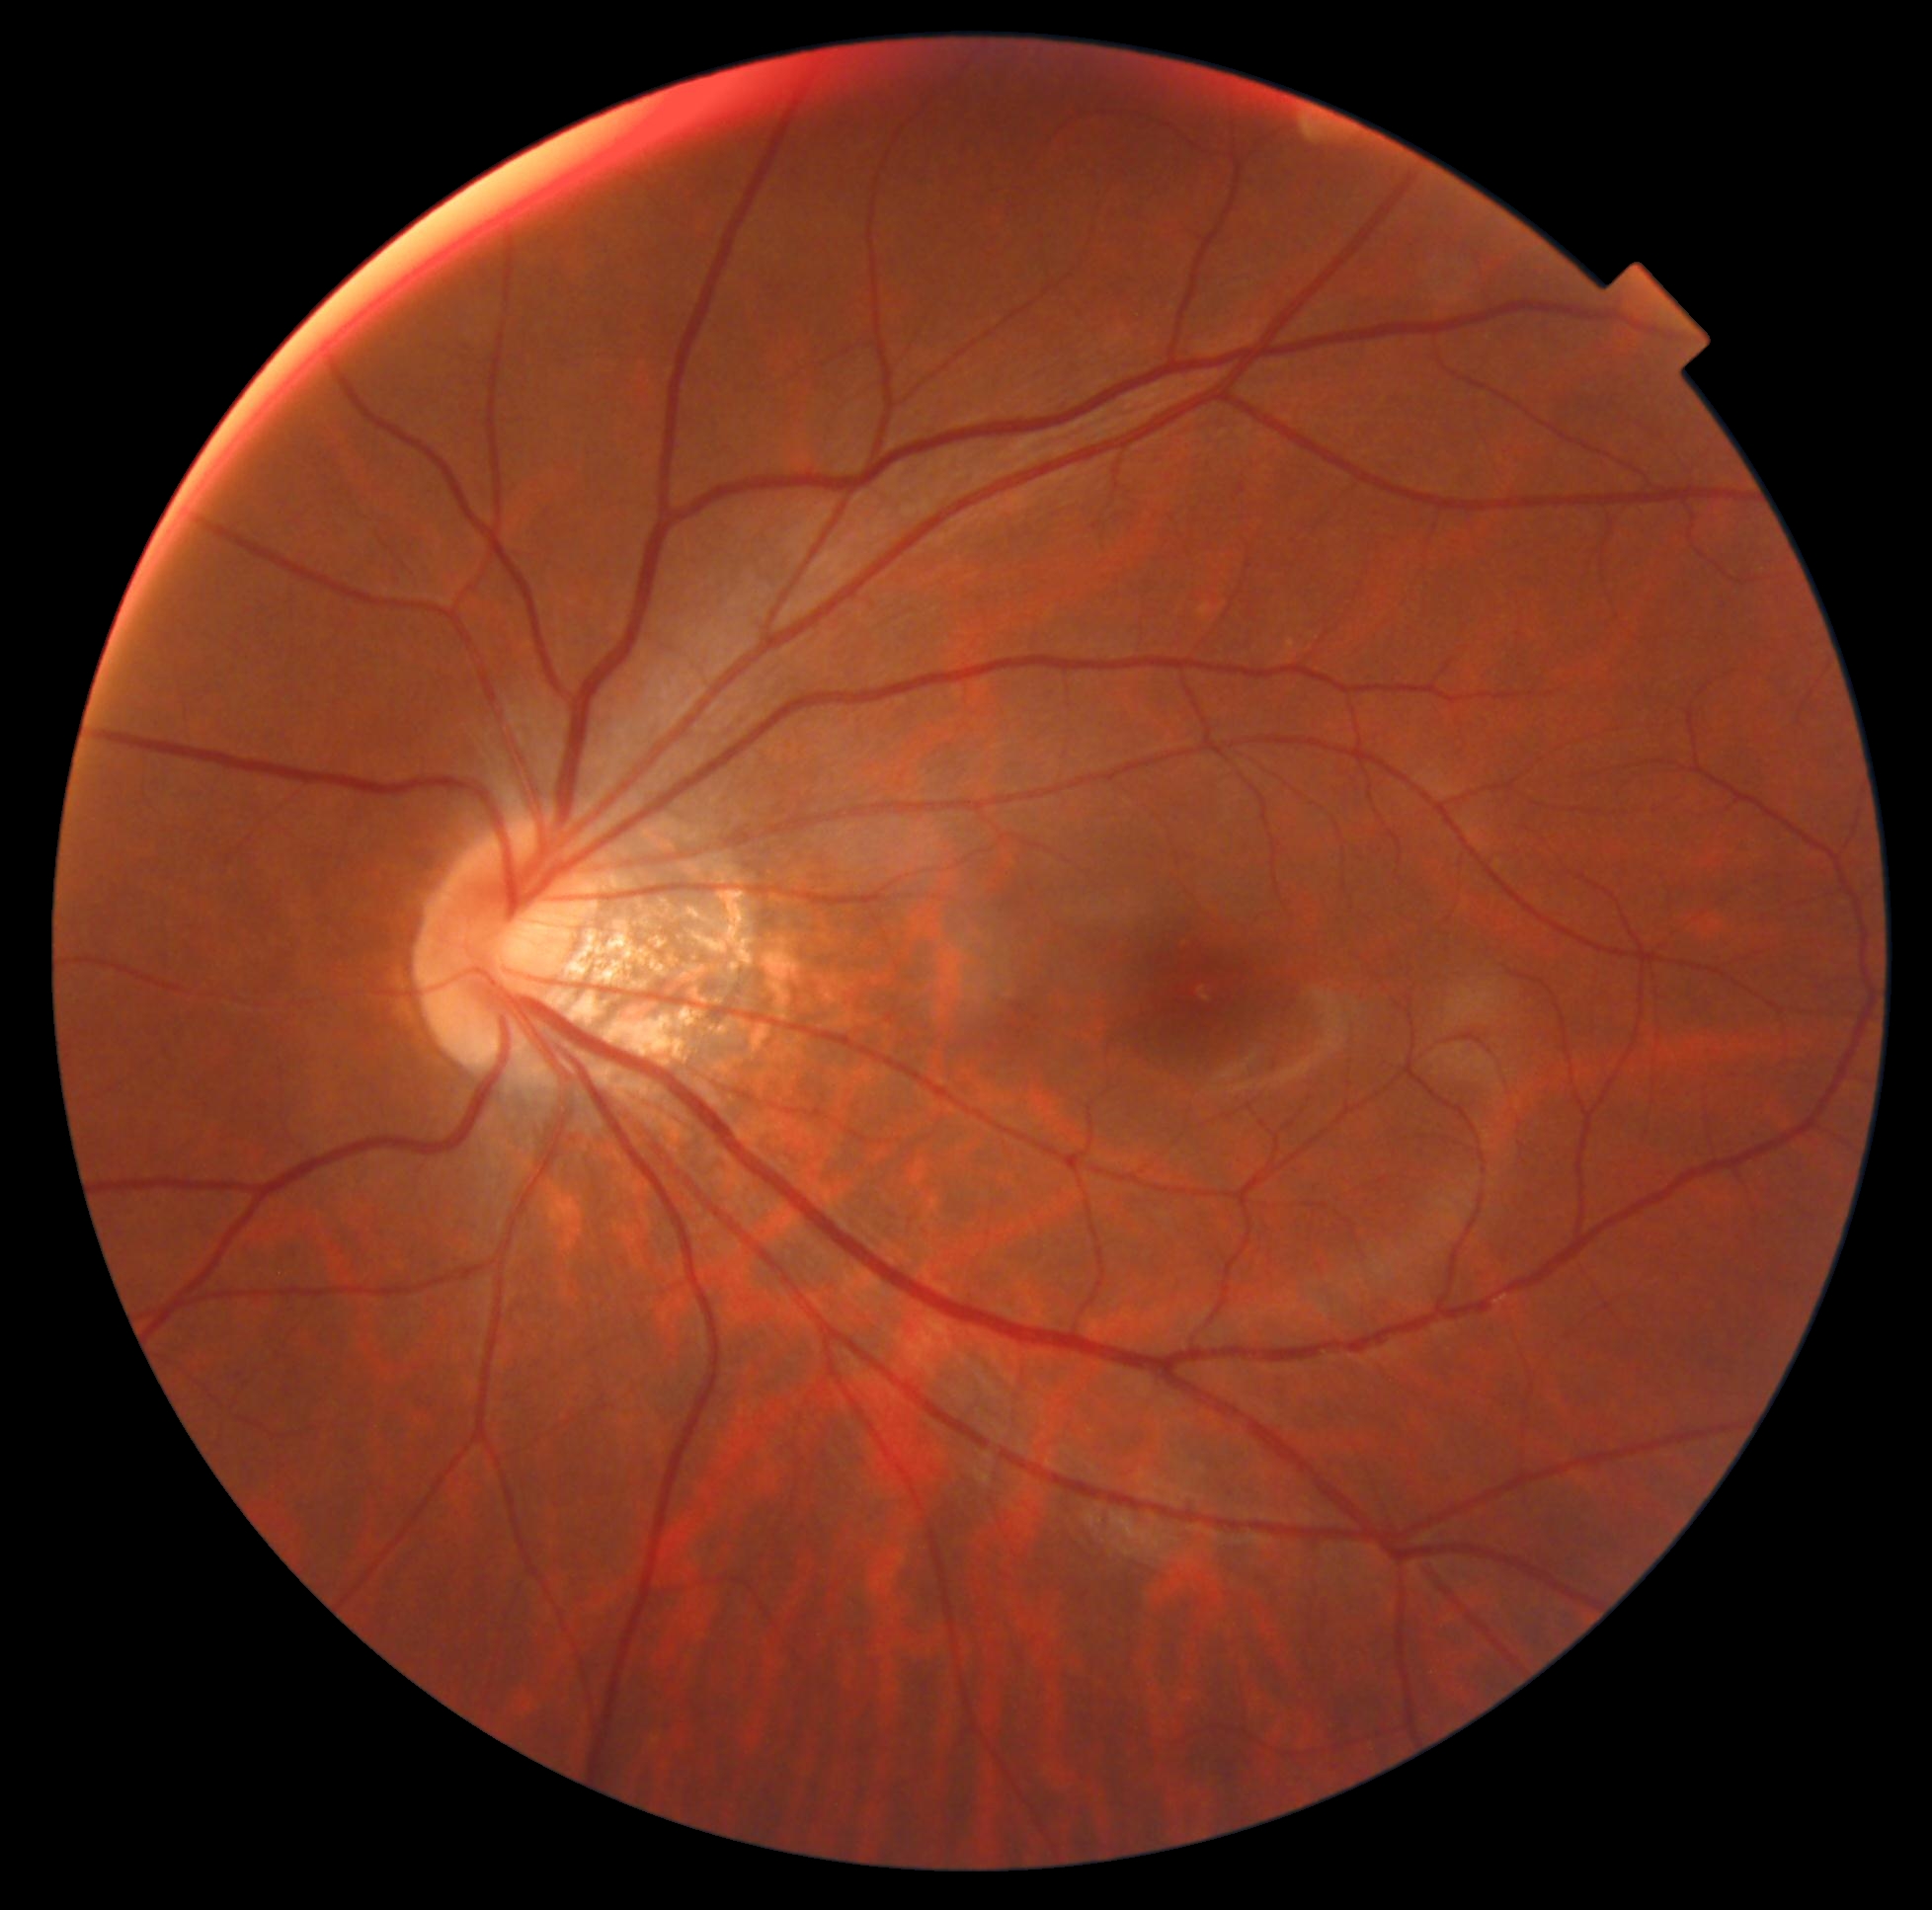

DR stage is 0/4. No signs of diabetic retinopathy.